Retinal fundus photograph. Image size 2212x1659.
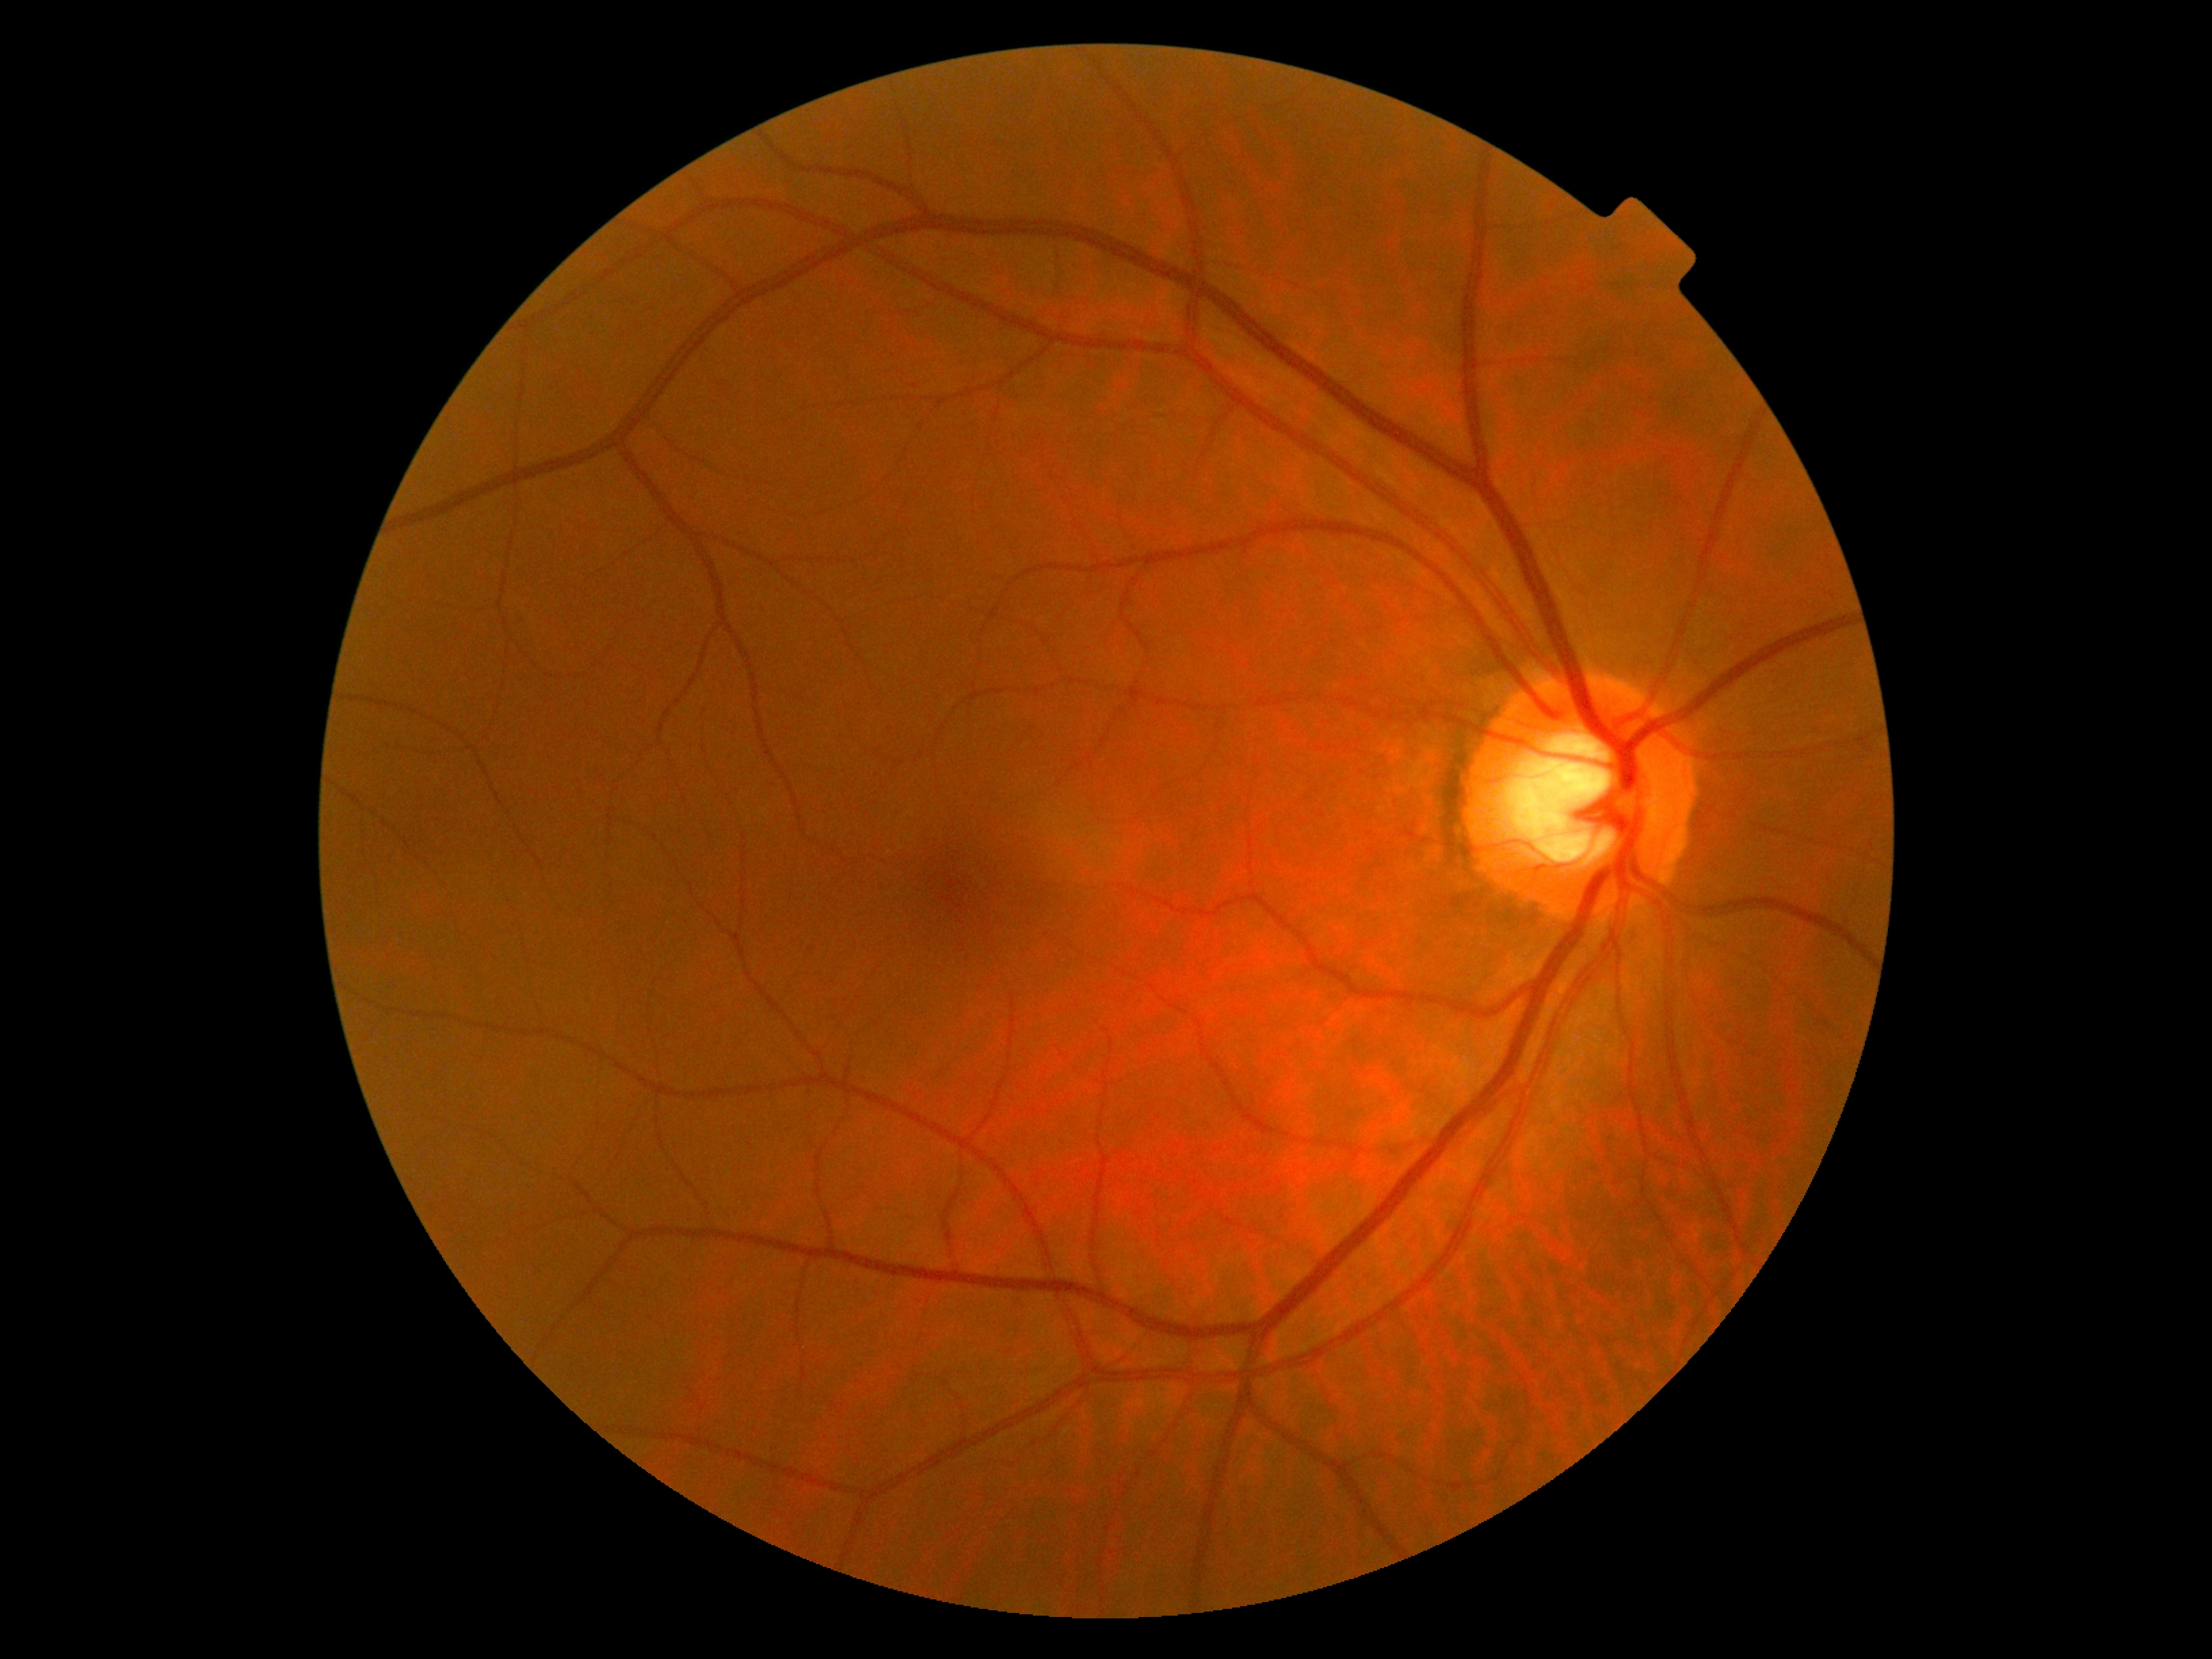

DR impression = no apparent DR | diabetic retinopathy = grade 0 (no apparent retinopathy).